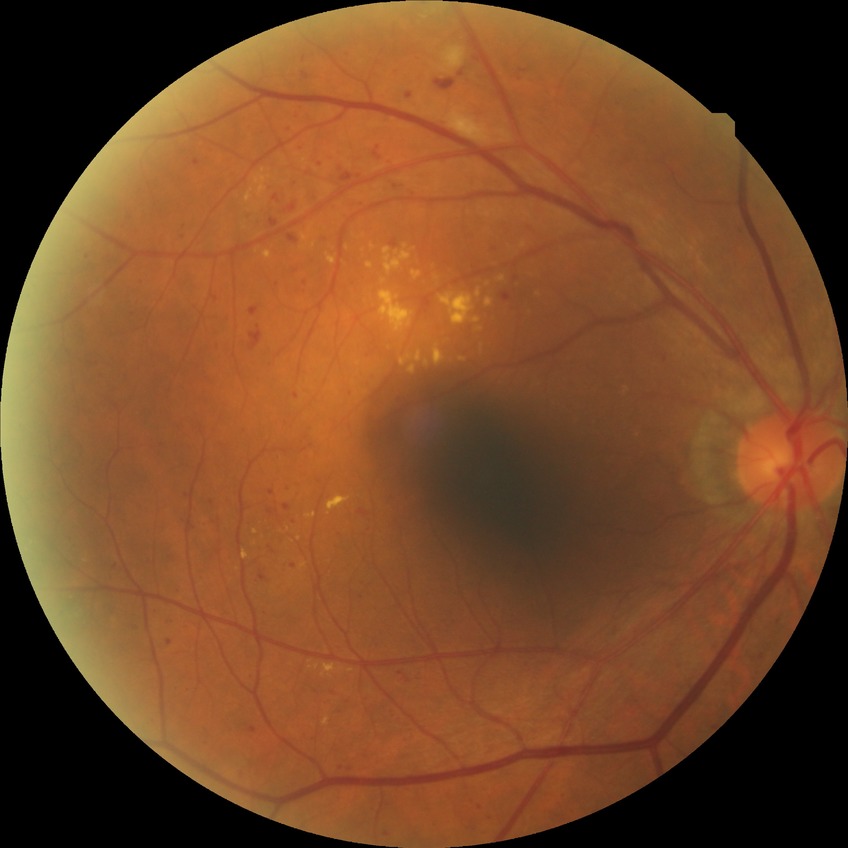
Davis DR grade: PPDR.